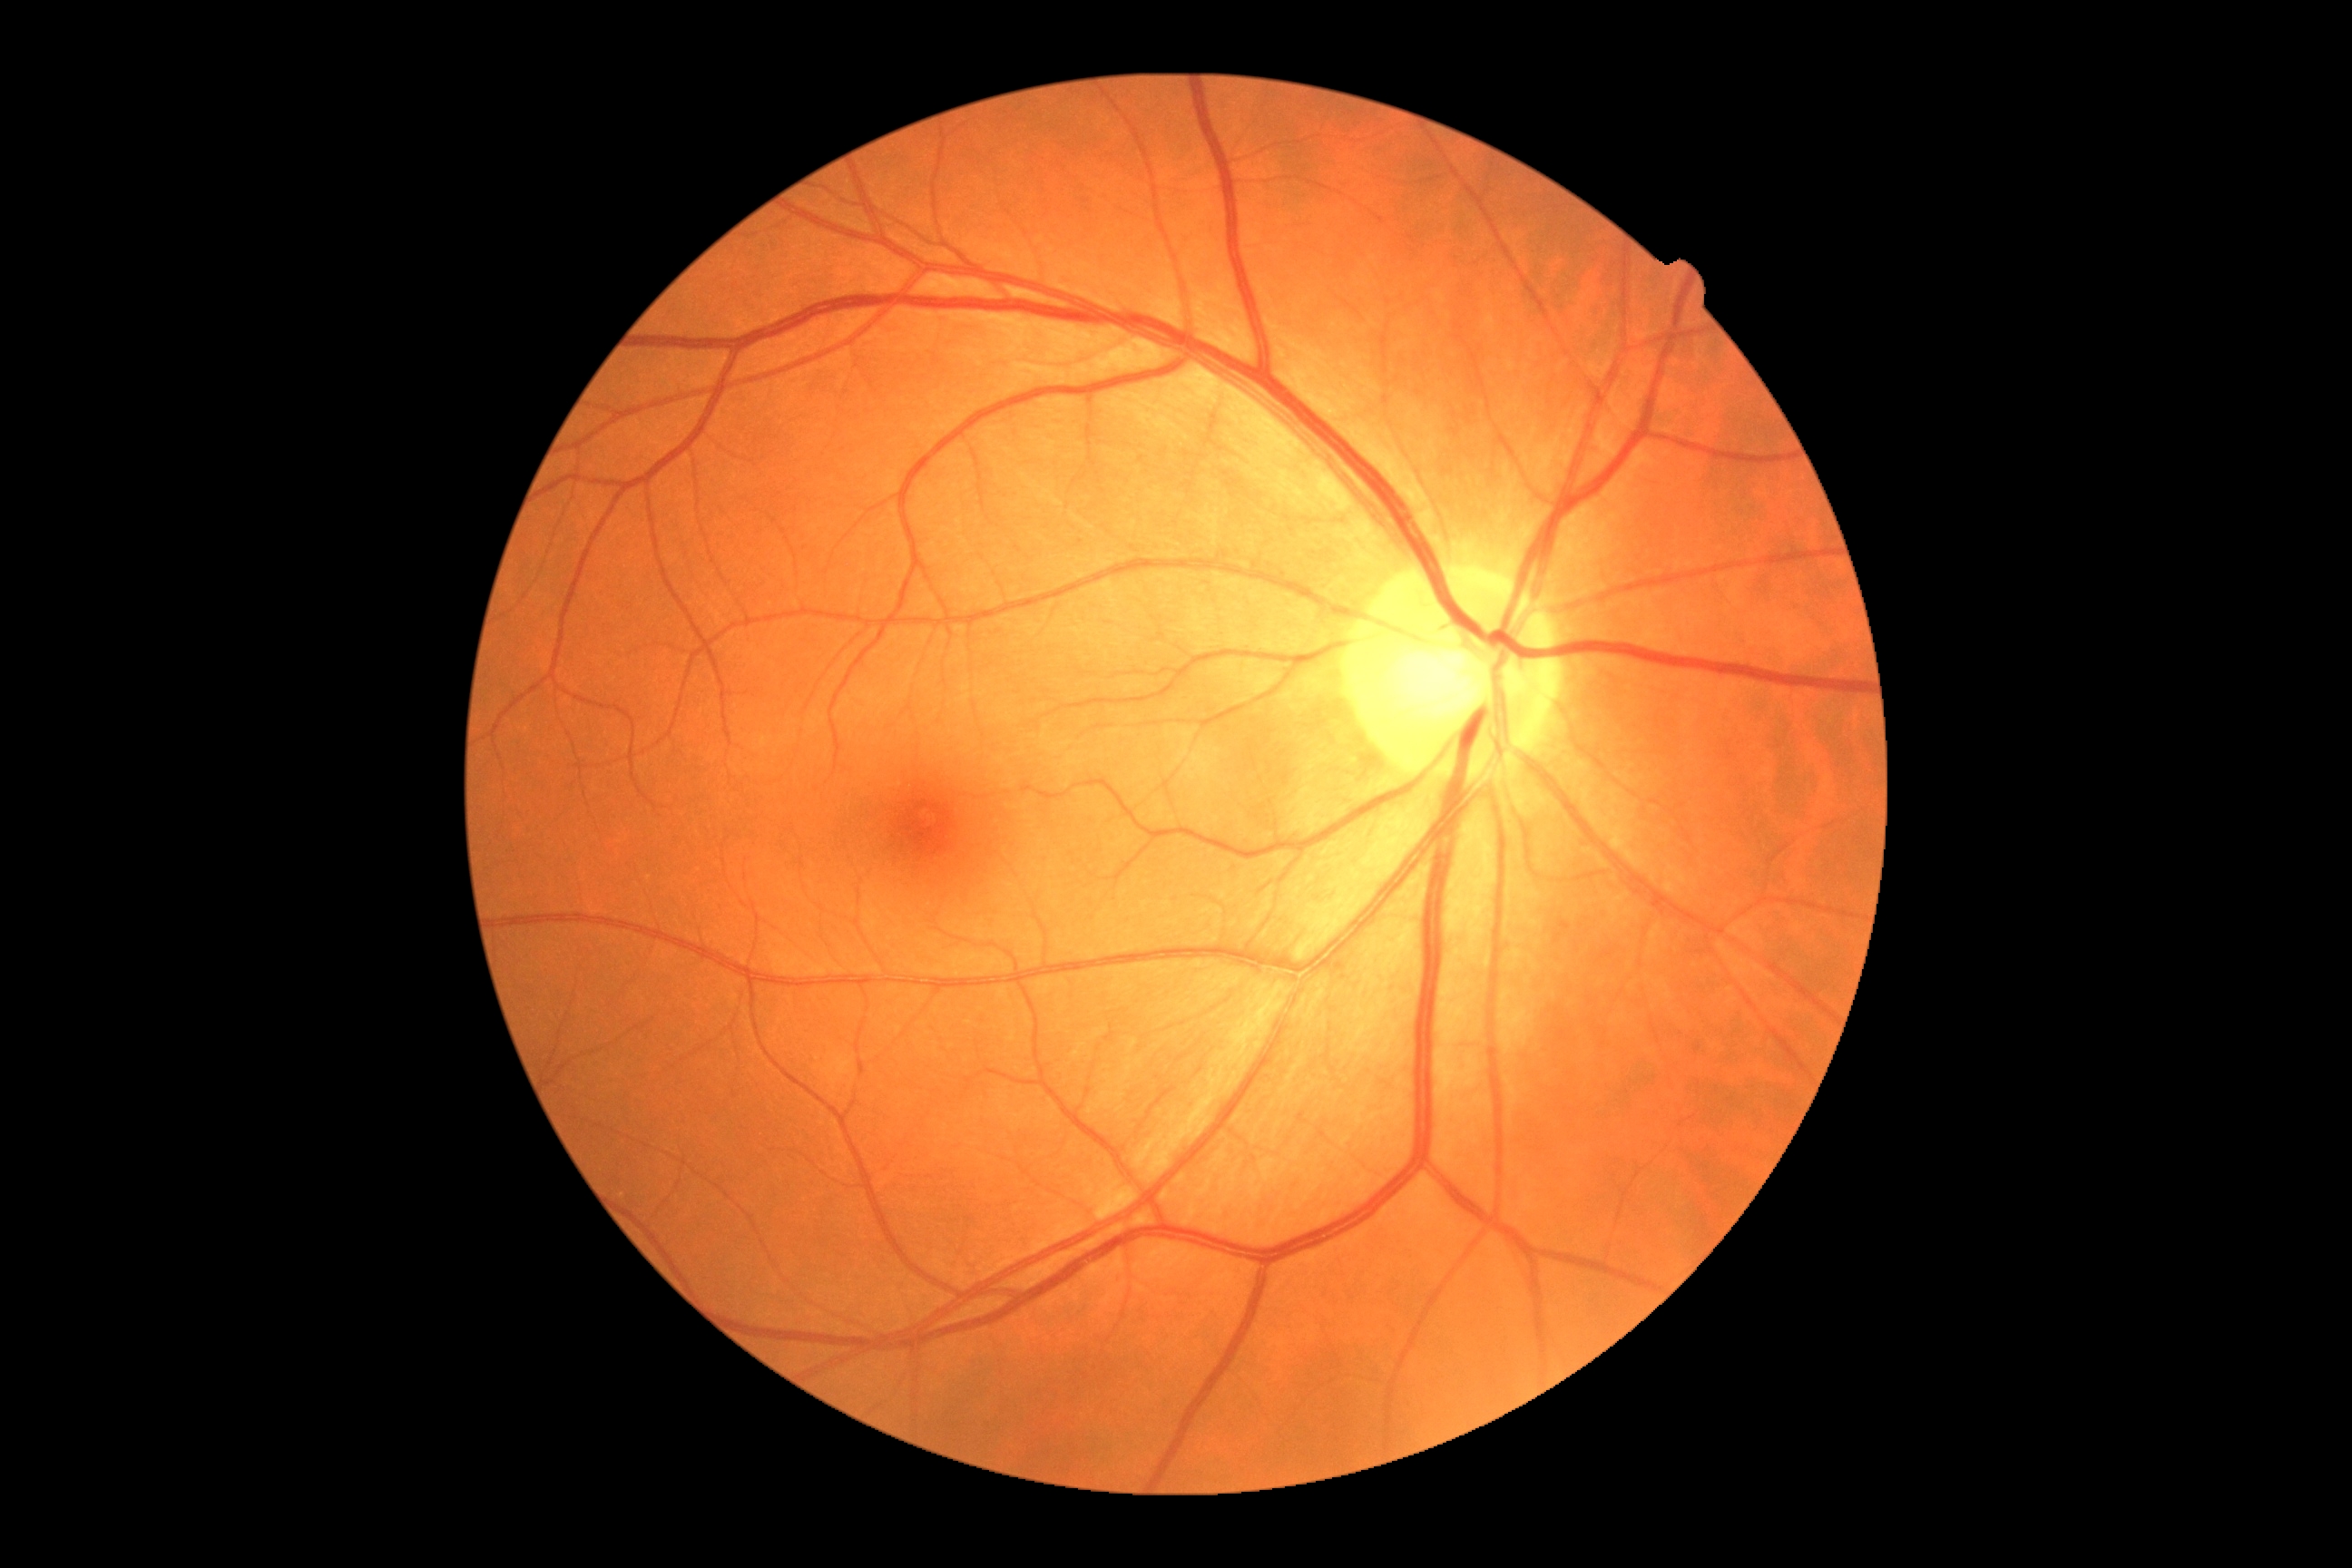
DR grade: 0 (no apparent retinopathy).